Pediatric wide-field fundus photograph
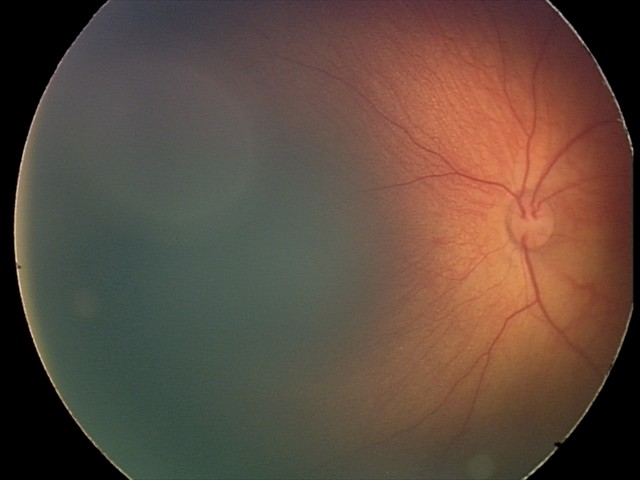 Diagnosis from this screening exam: retinal hemorrhages.